2212 by 1659 pixels; color fundus image:
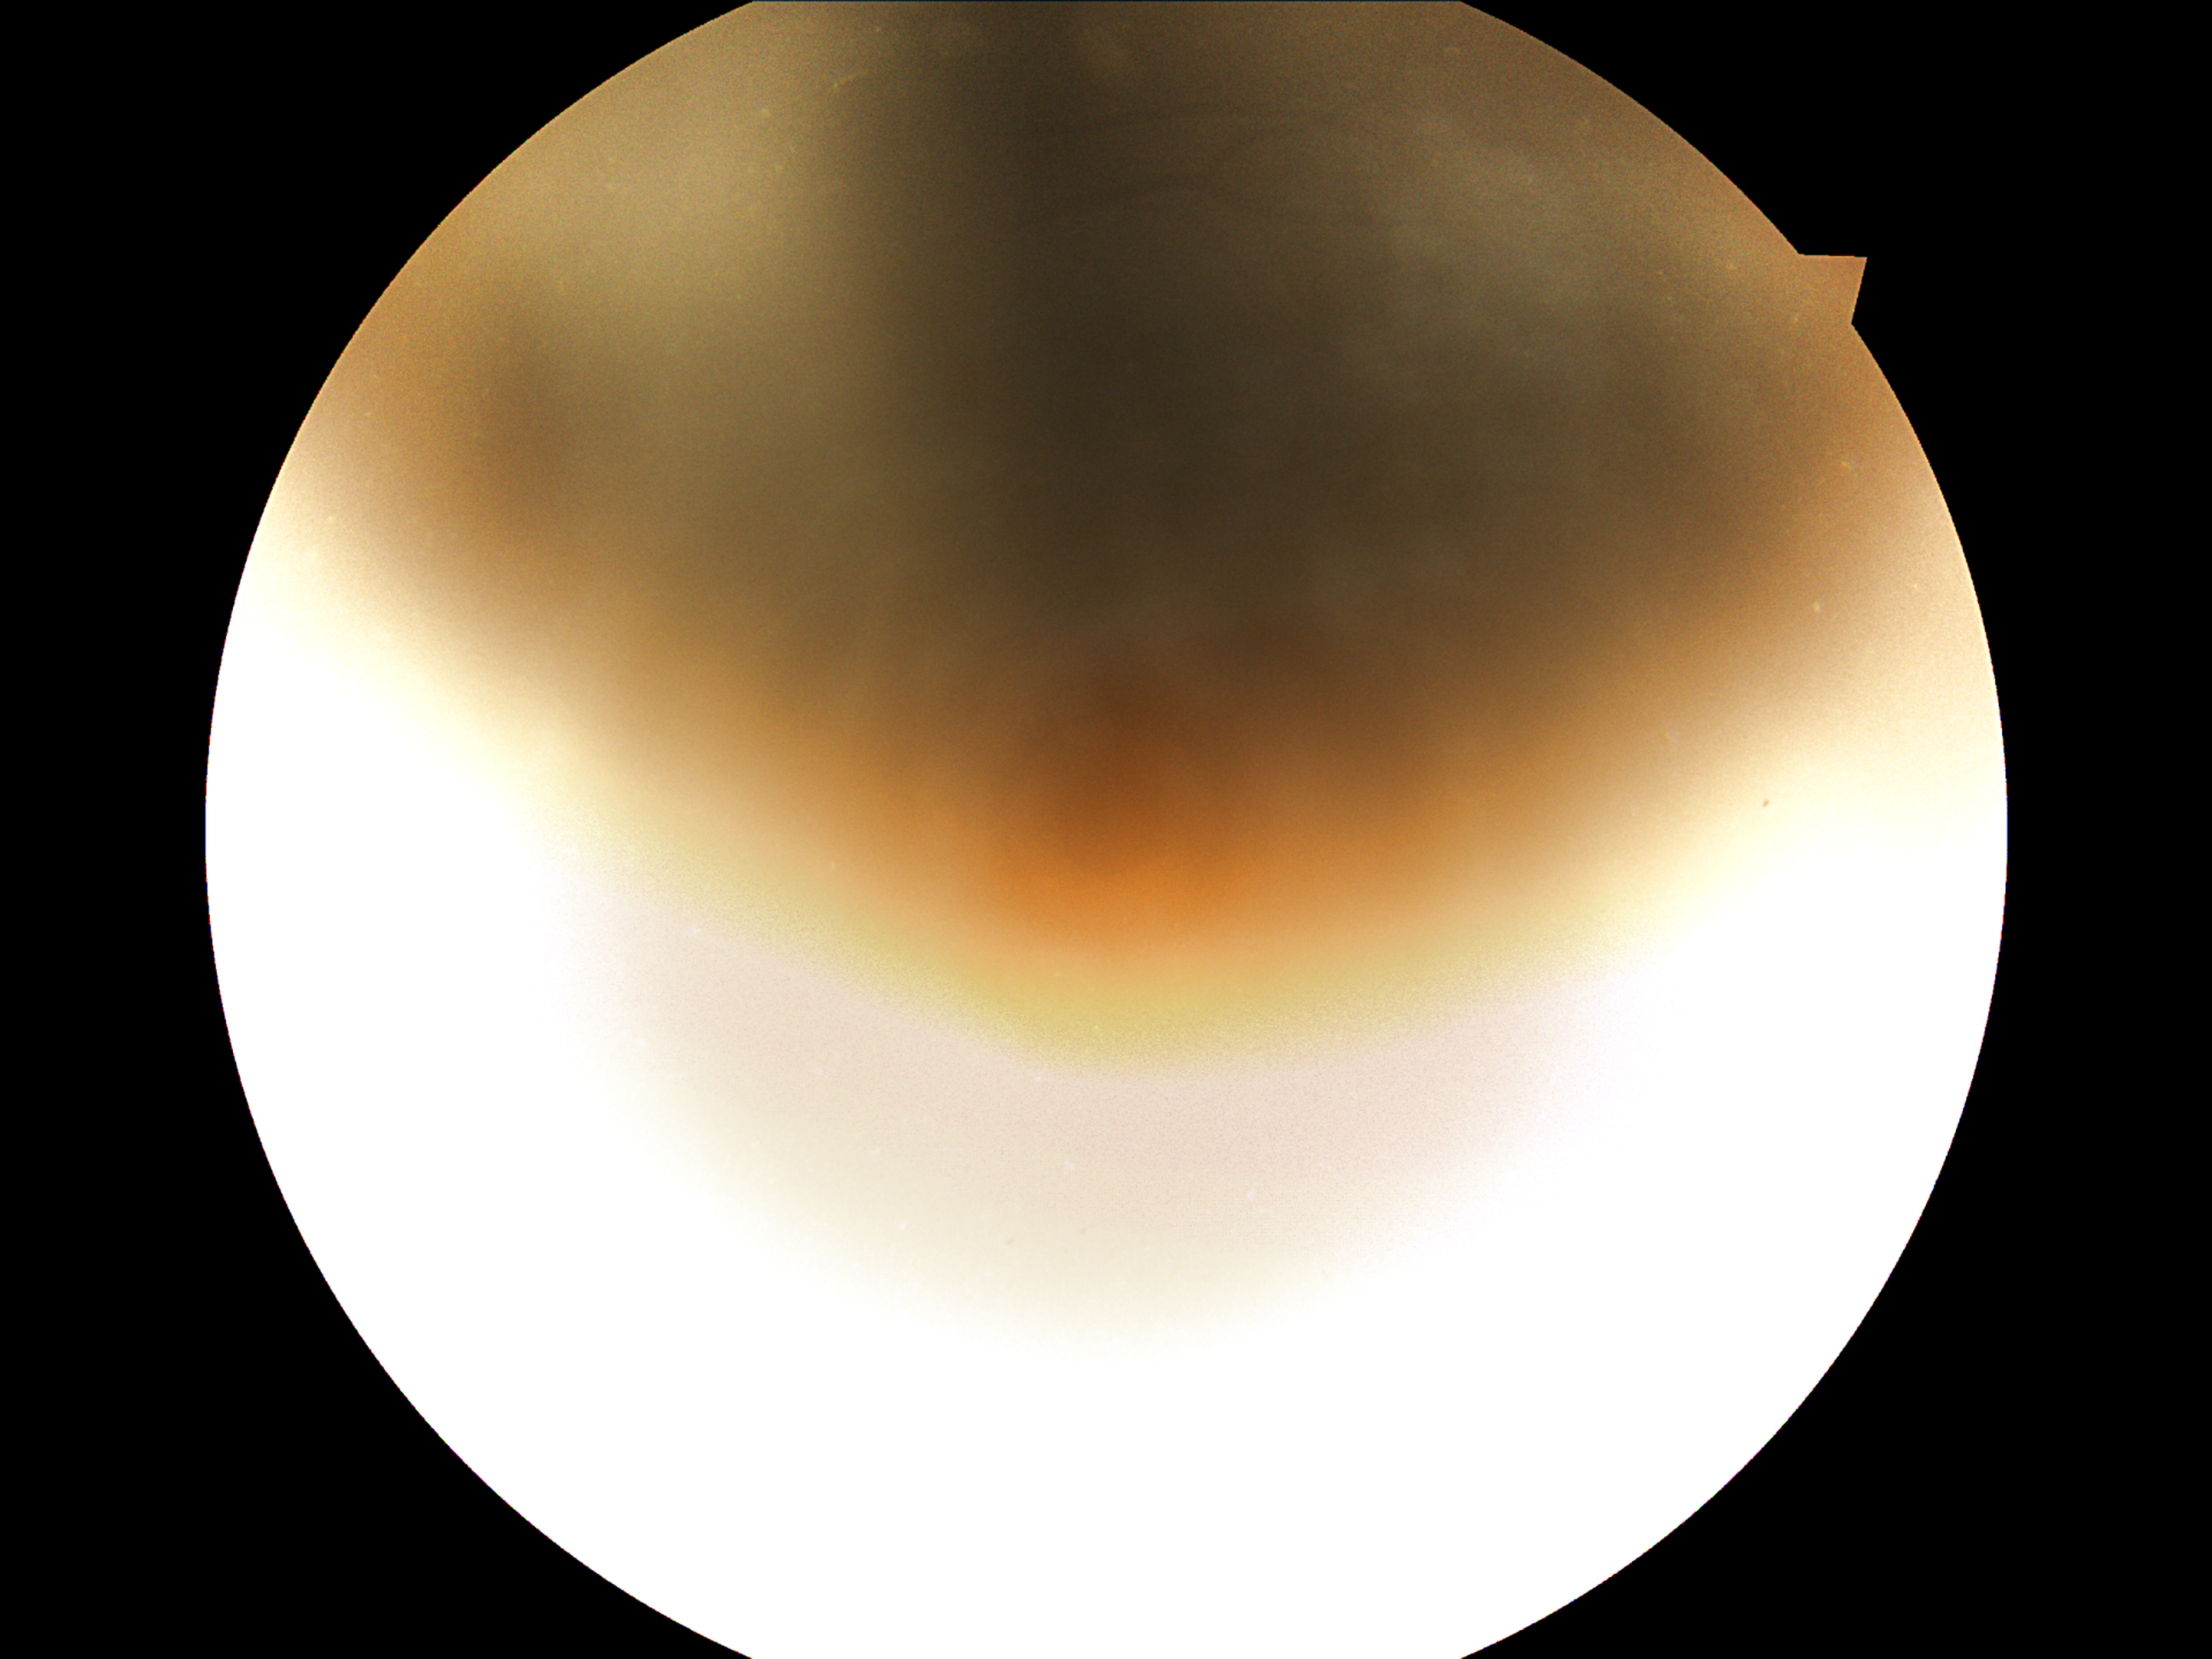

retinopathy: ungradable due to poor image quality; image quality: too poor for DR grading.